Color fundus photograph.
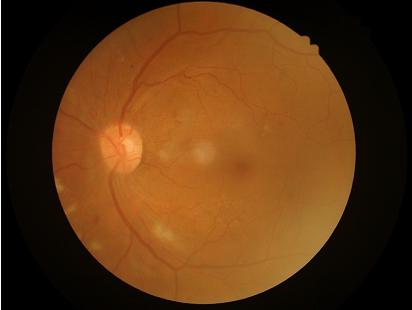

Reduced sharpness with visible blur. Even illumination with no color cast. Acceptable image quality. Good dynamic range.